Infant wide-field retinal image. Clarity RetCam 3, 130° FOV.
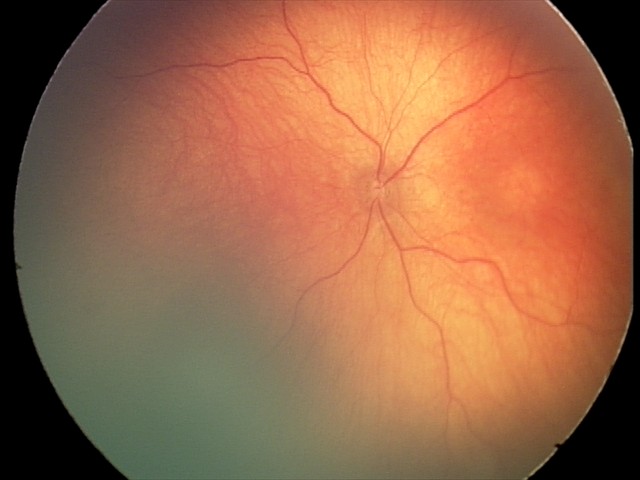 Q: What was the screening finding?
A: normal fundus examination